Wide-field contact fundus photograph of an infant — 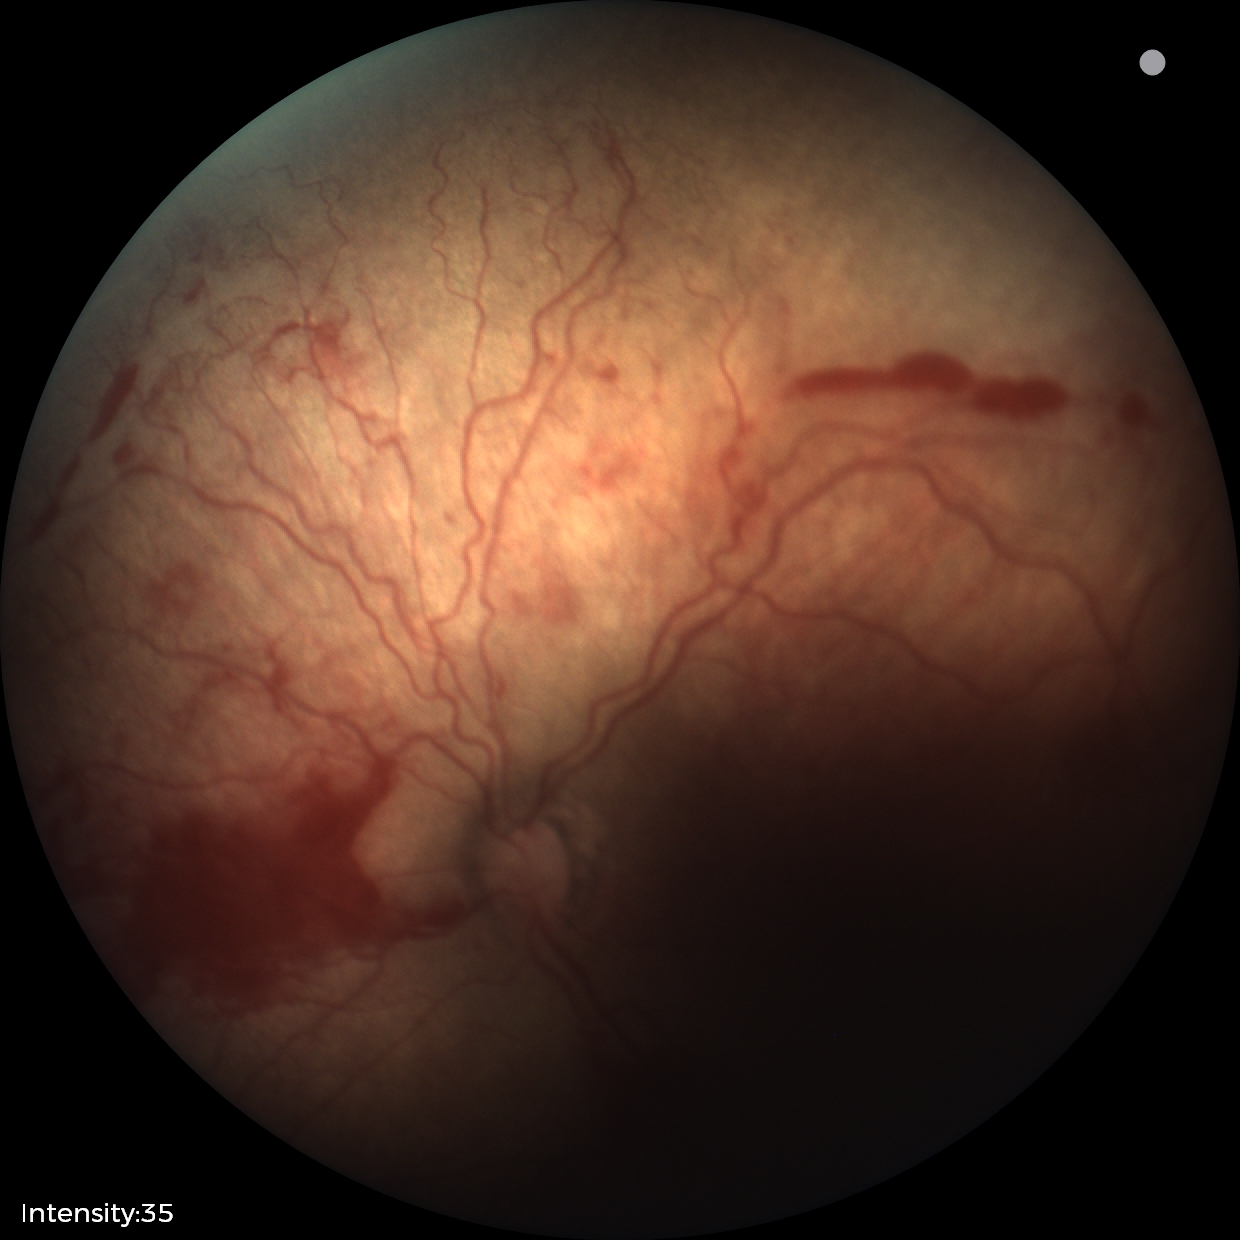
Diagnosis from this screening exam: retinopathy of prematurity stage 2.
With plus disease.